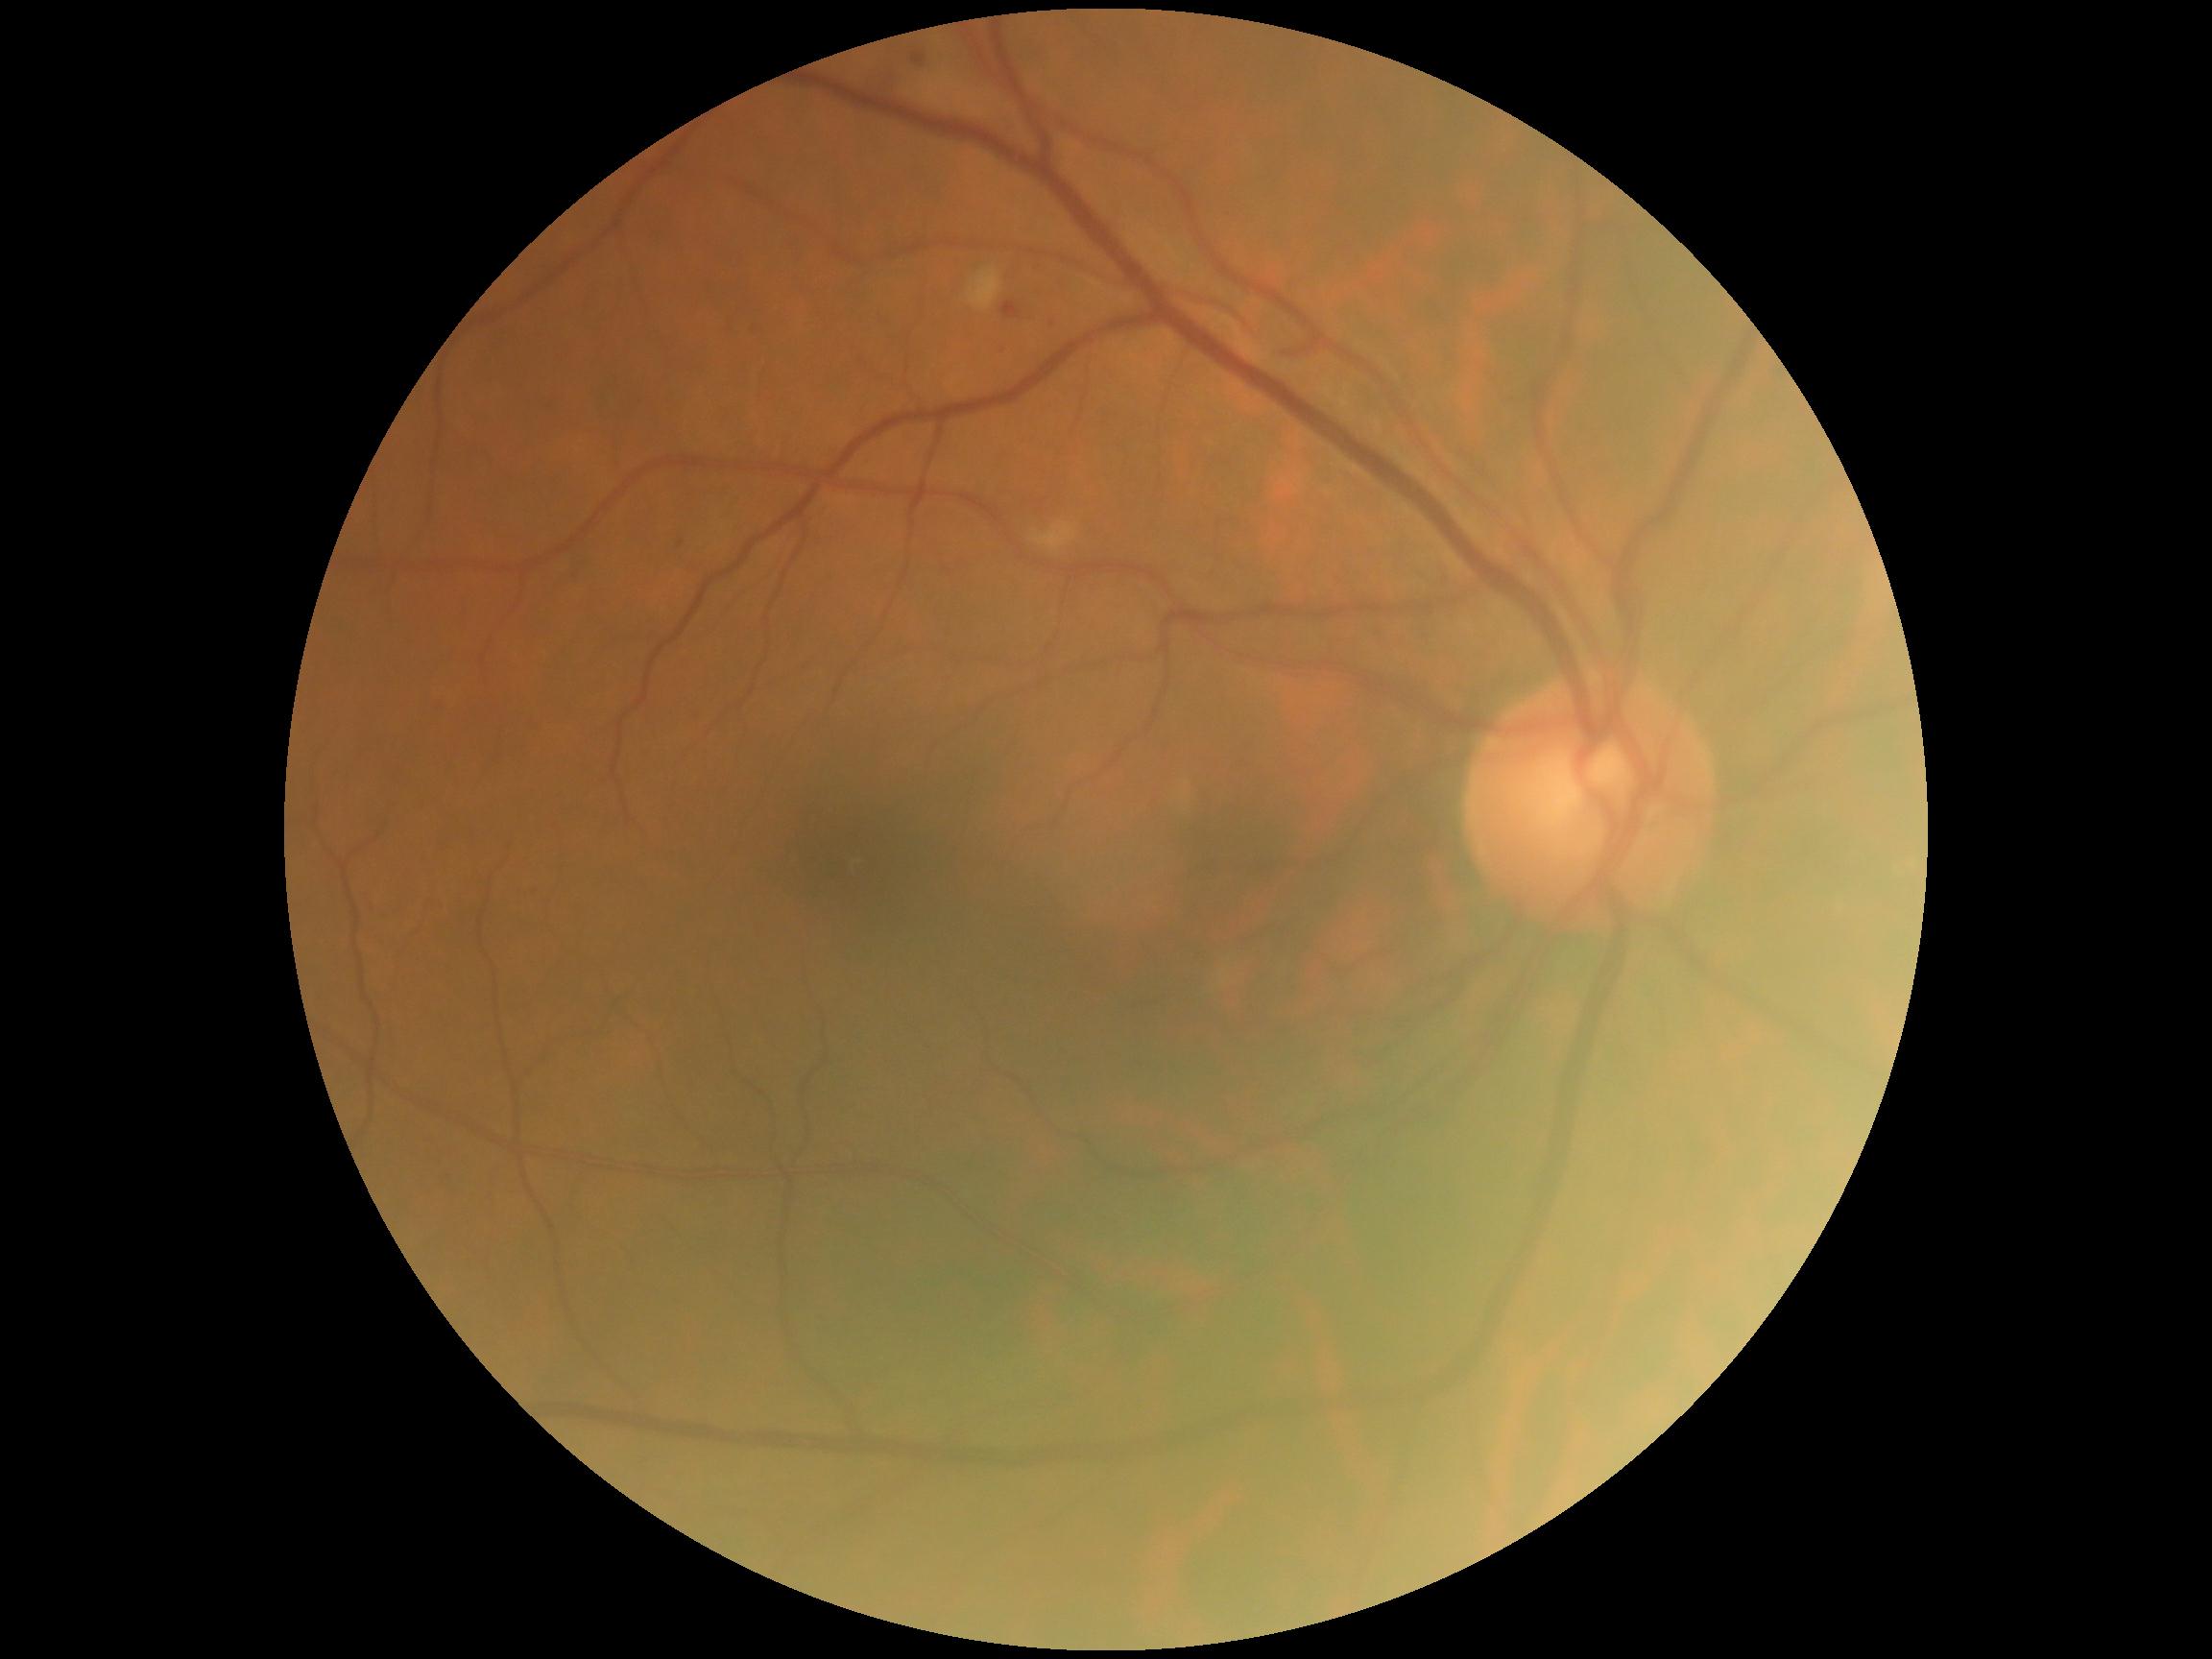

diabetic retinopathy (DR) = moderate non-proliferative diabetic retinopathy (grade 2)